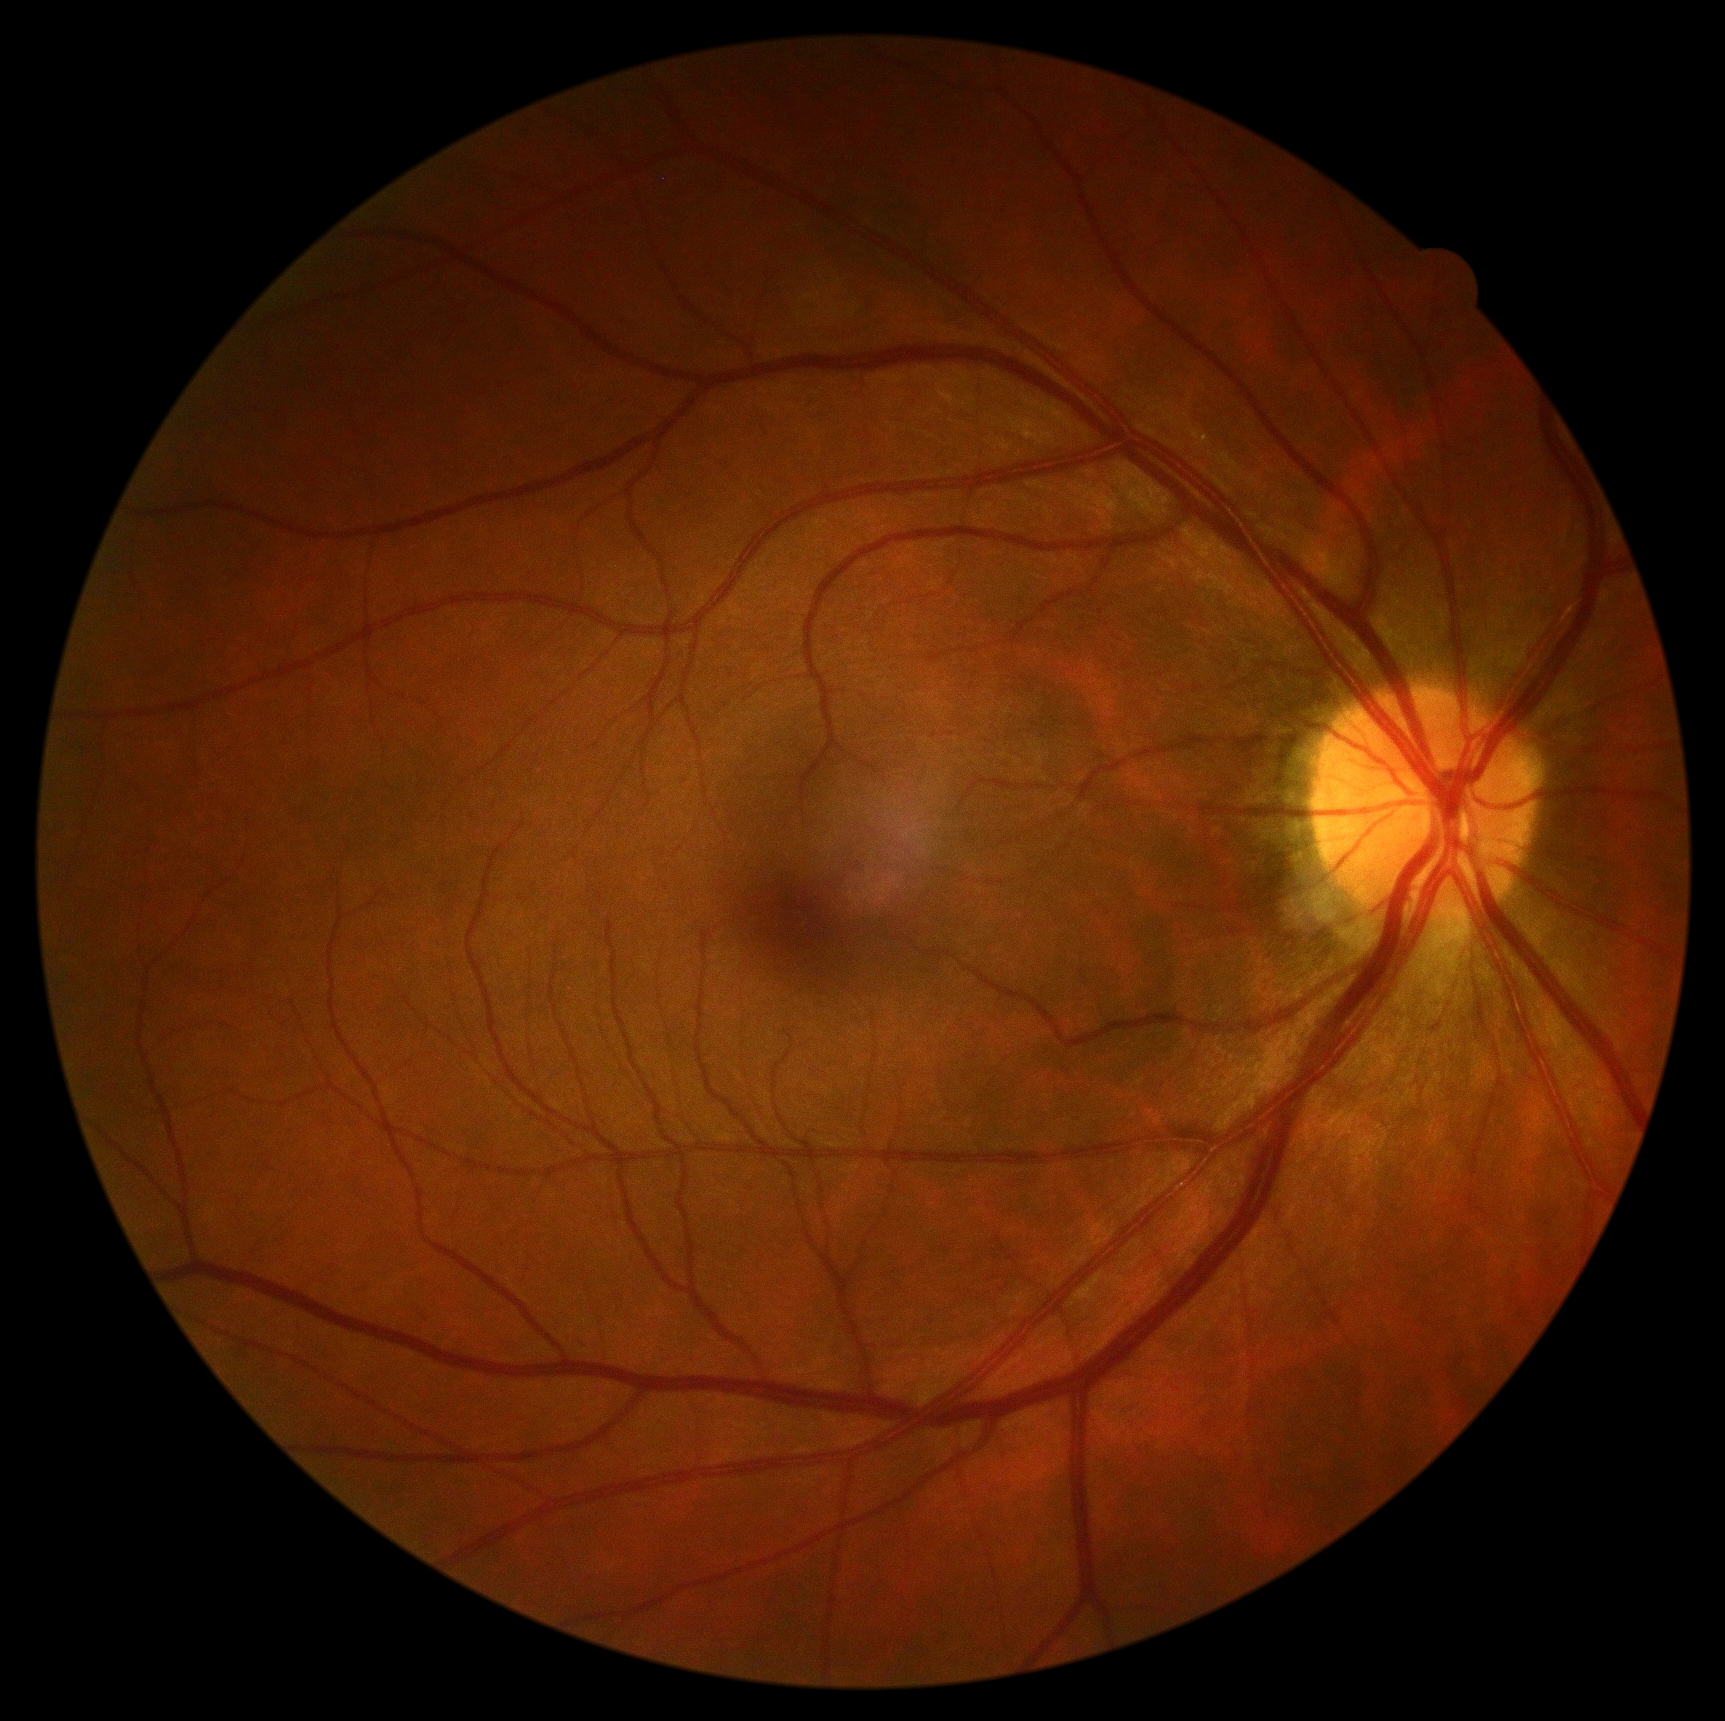
Retinopathy: 0/4.